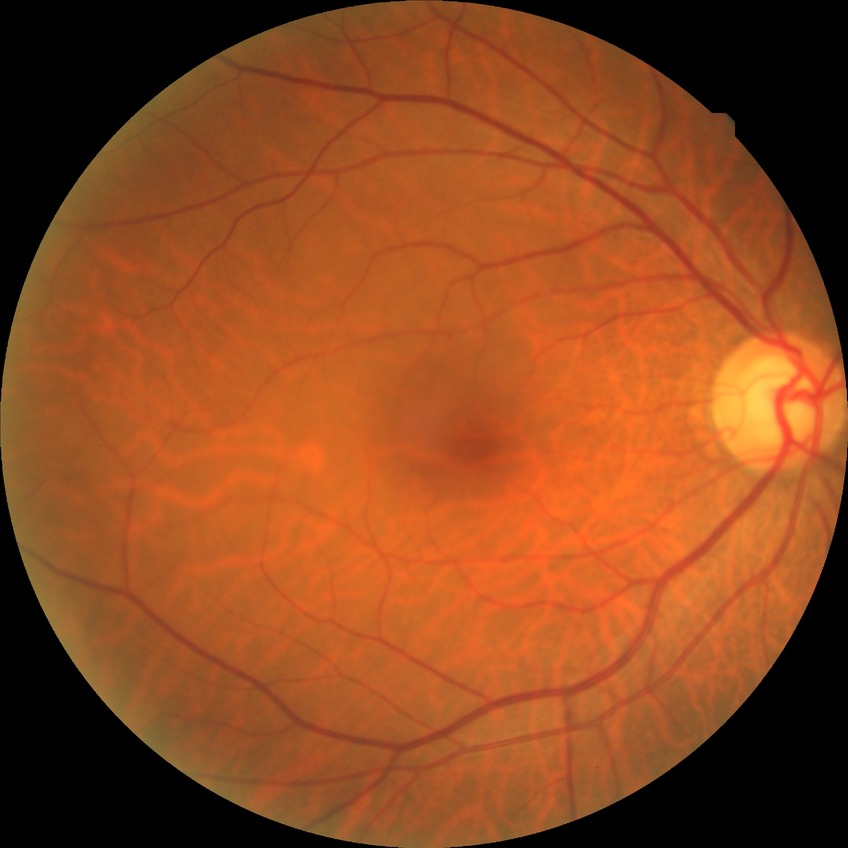
DR impression@no signs of DR; Davis grade@NDR.